45-degree field of view. Color fundus photograph: 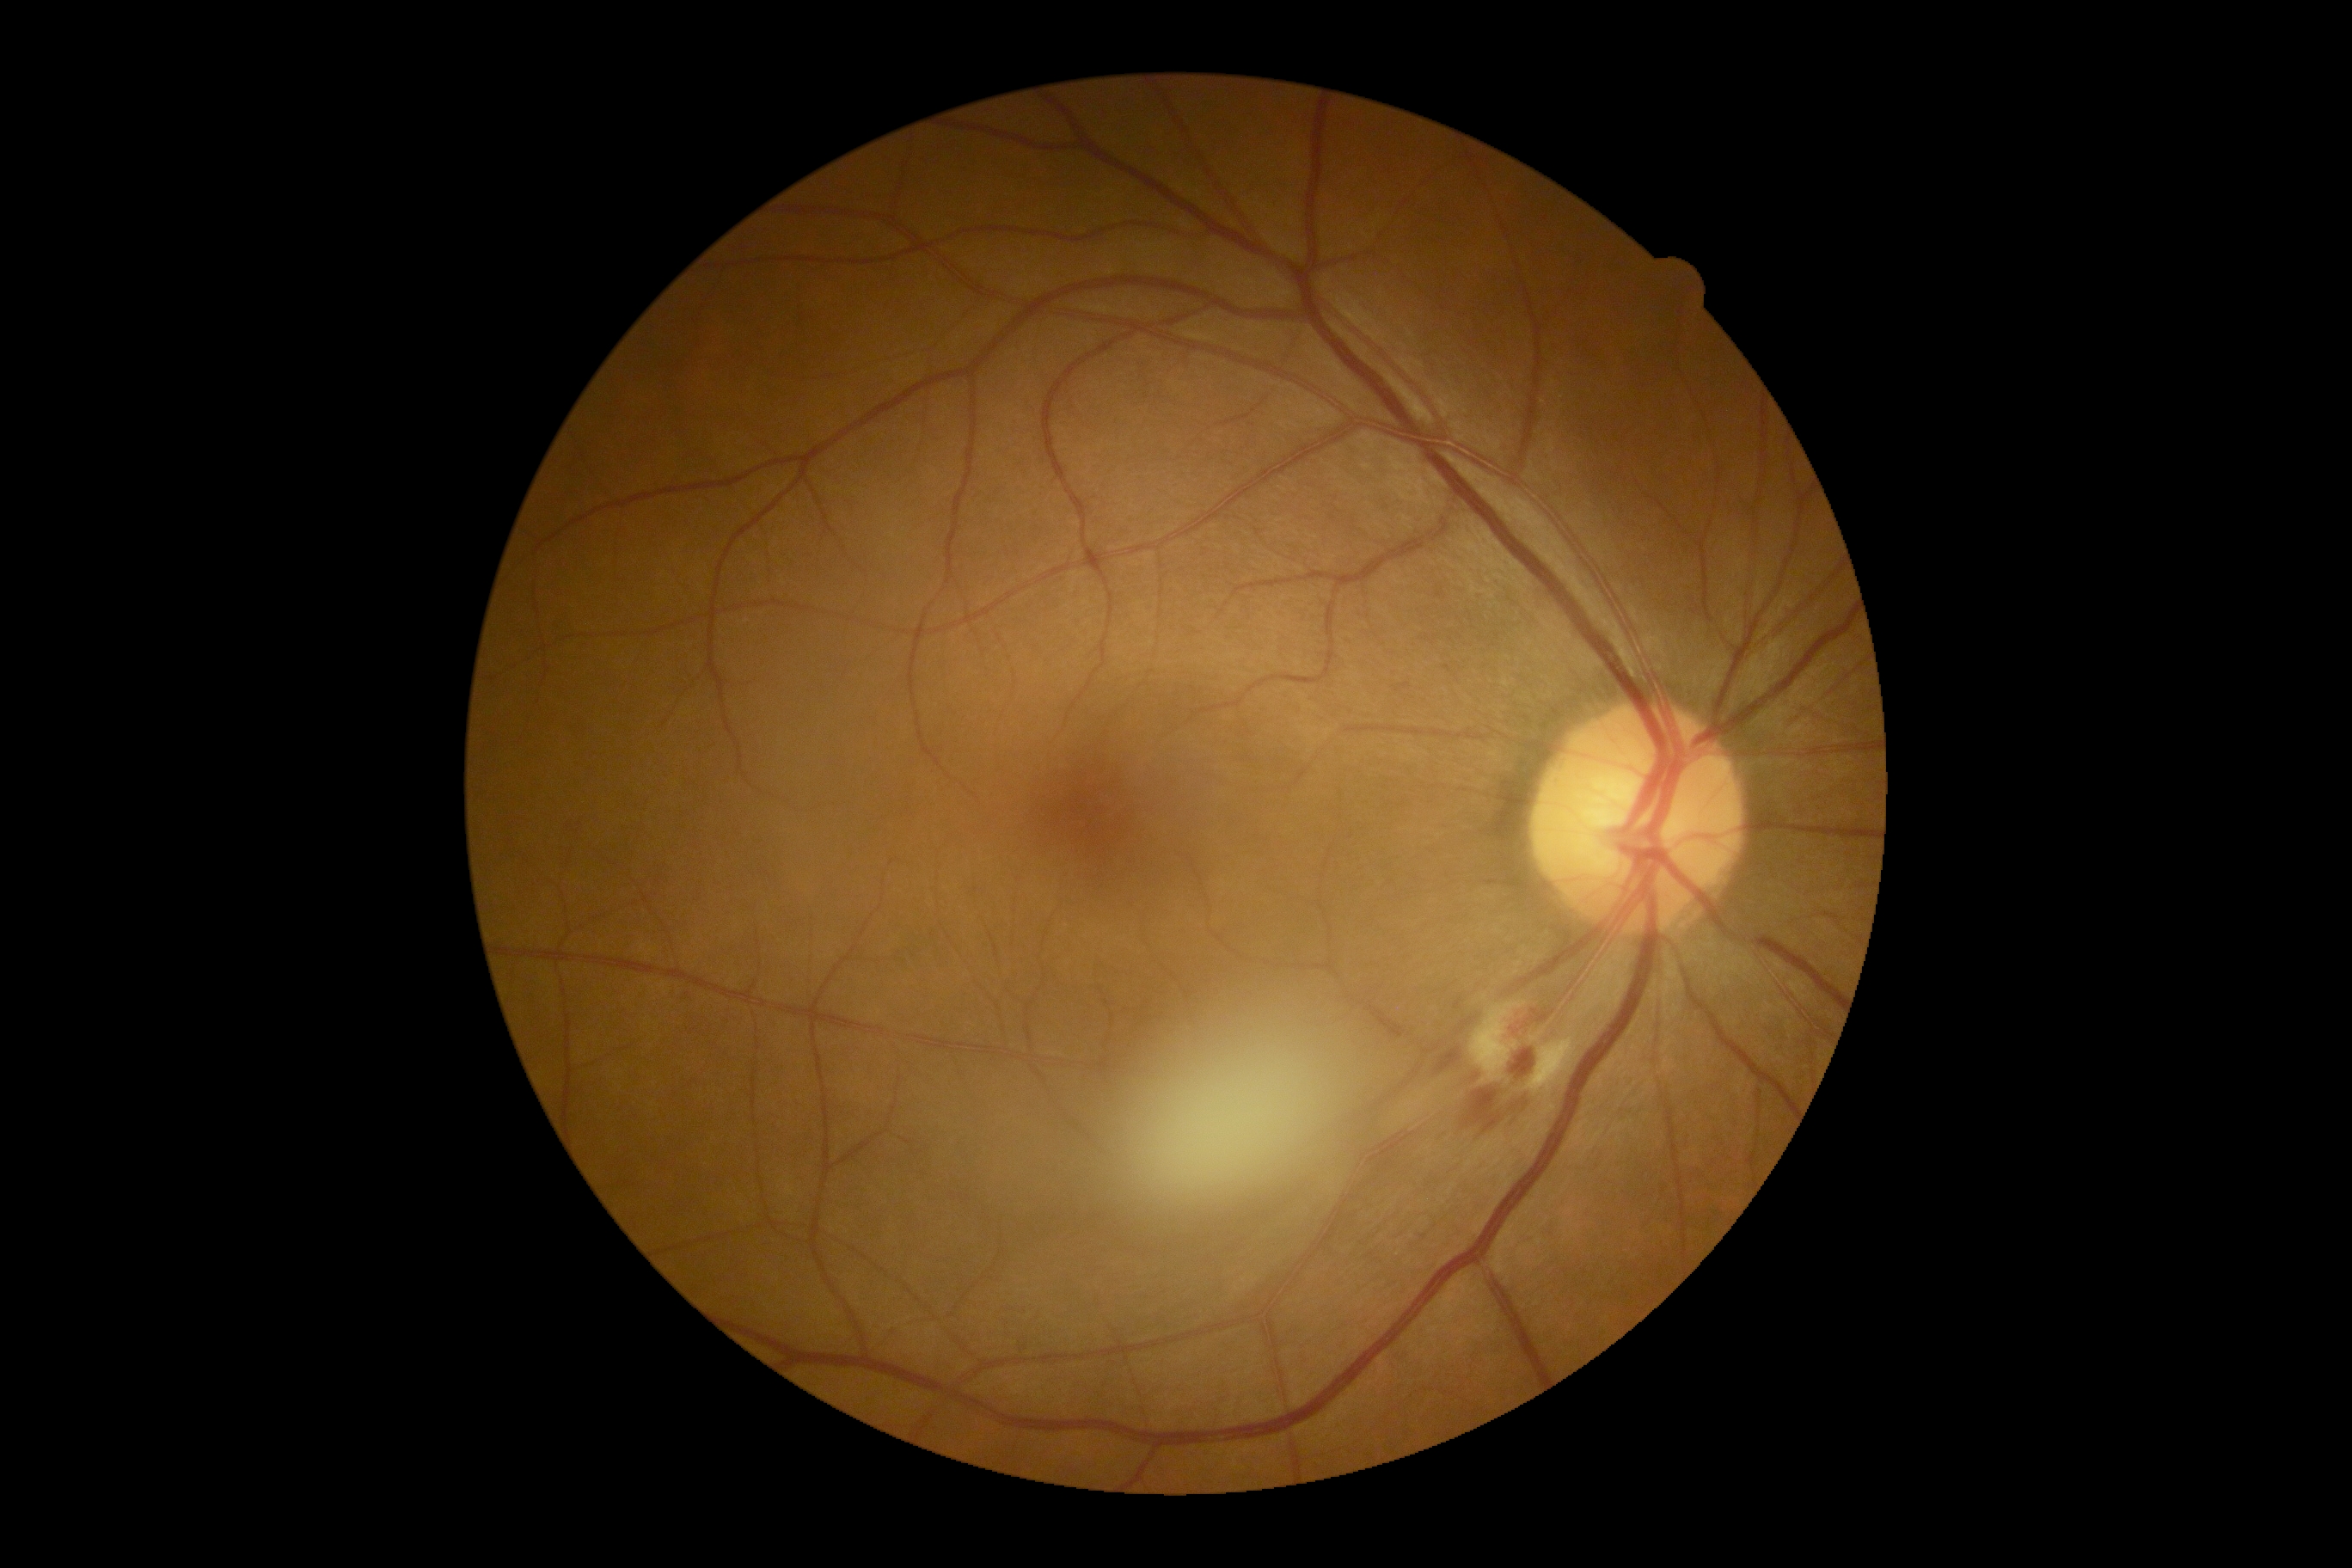

dr_grade: 2/4